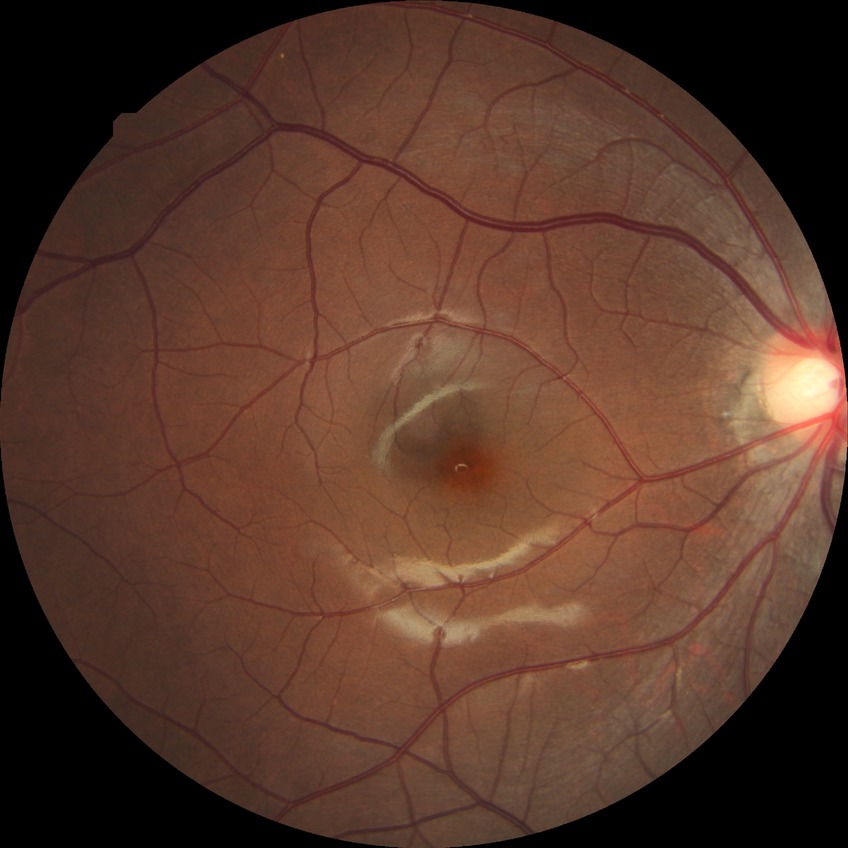
Diabetic retinopathy (DR): no diabetic retinopathy (NDR).